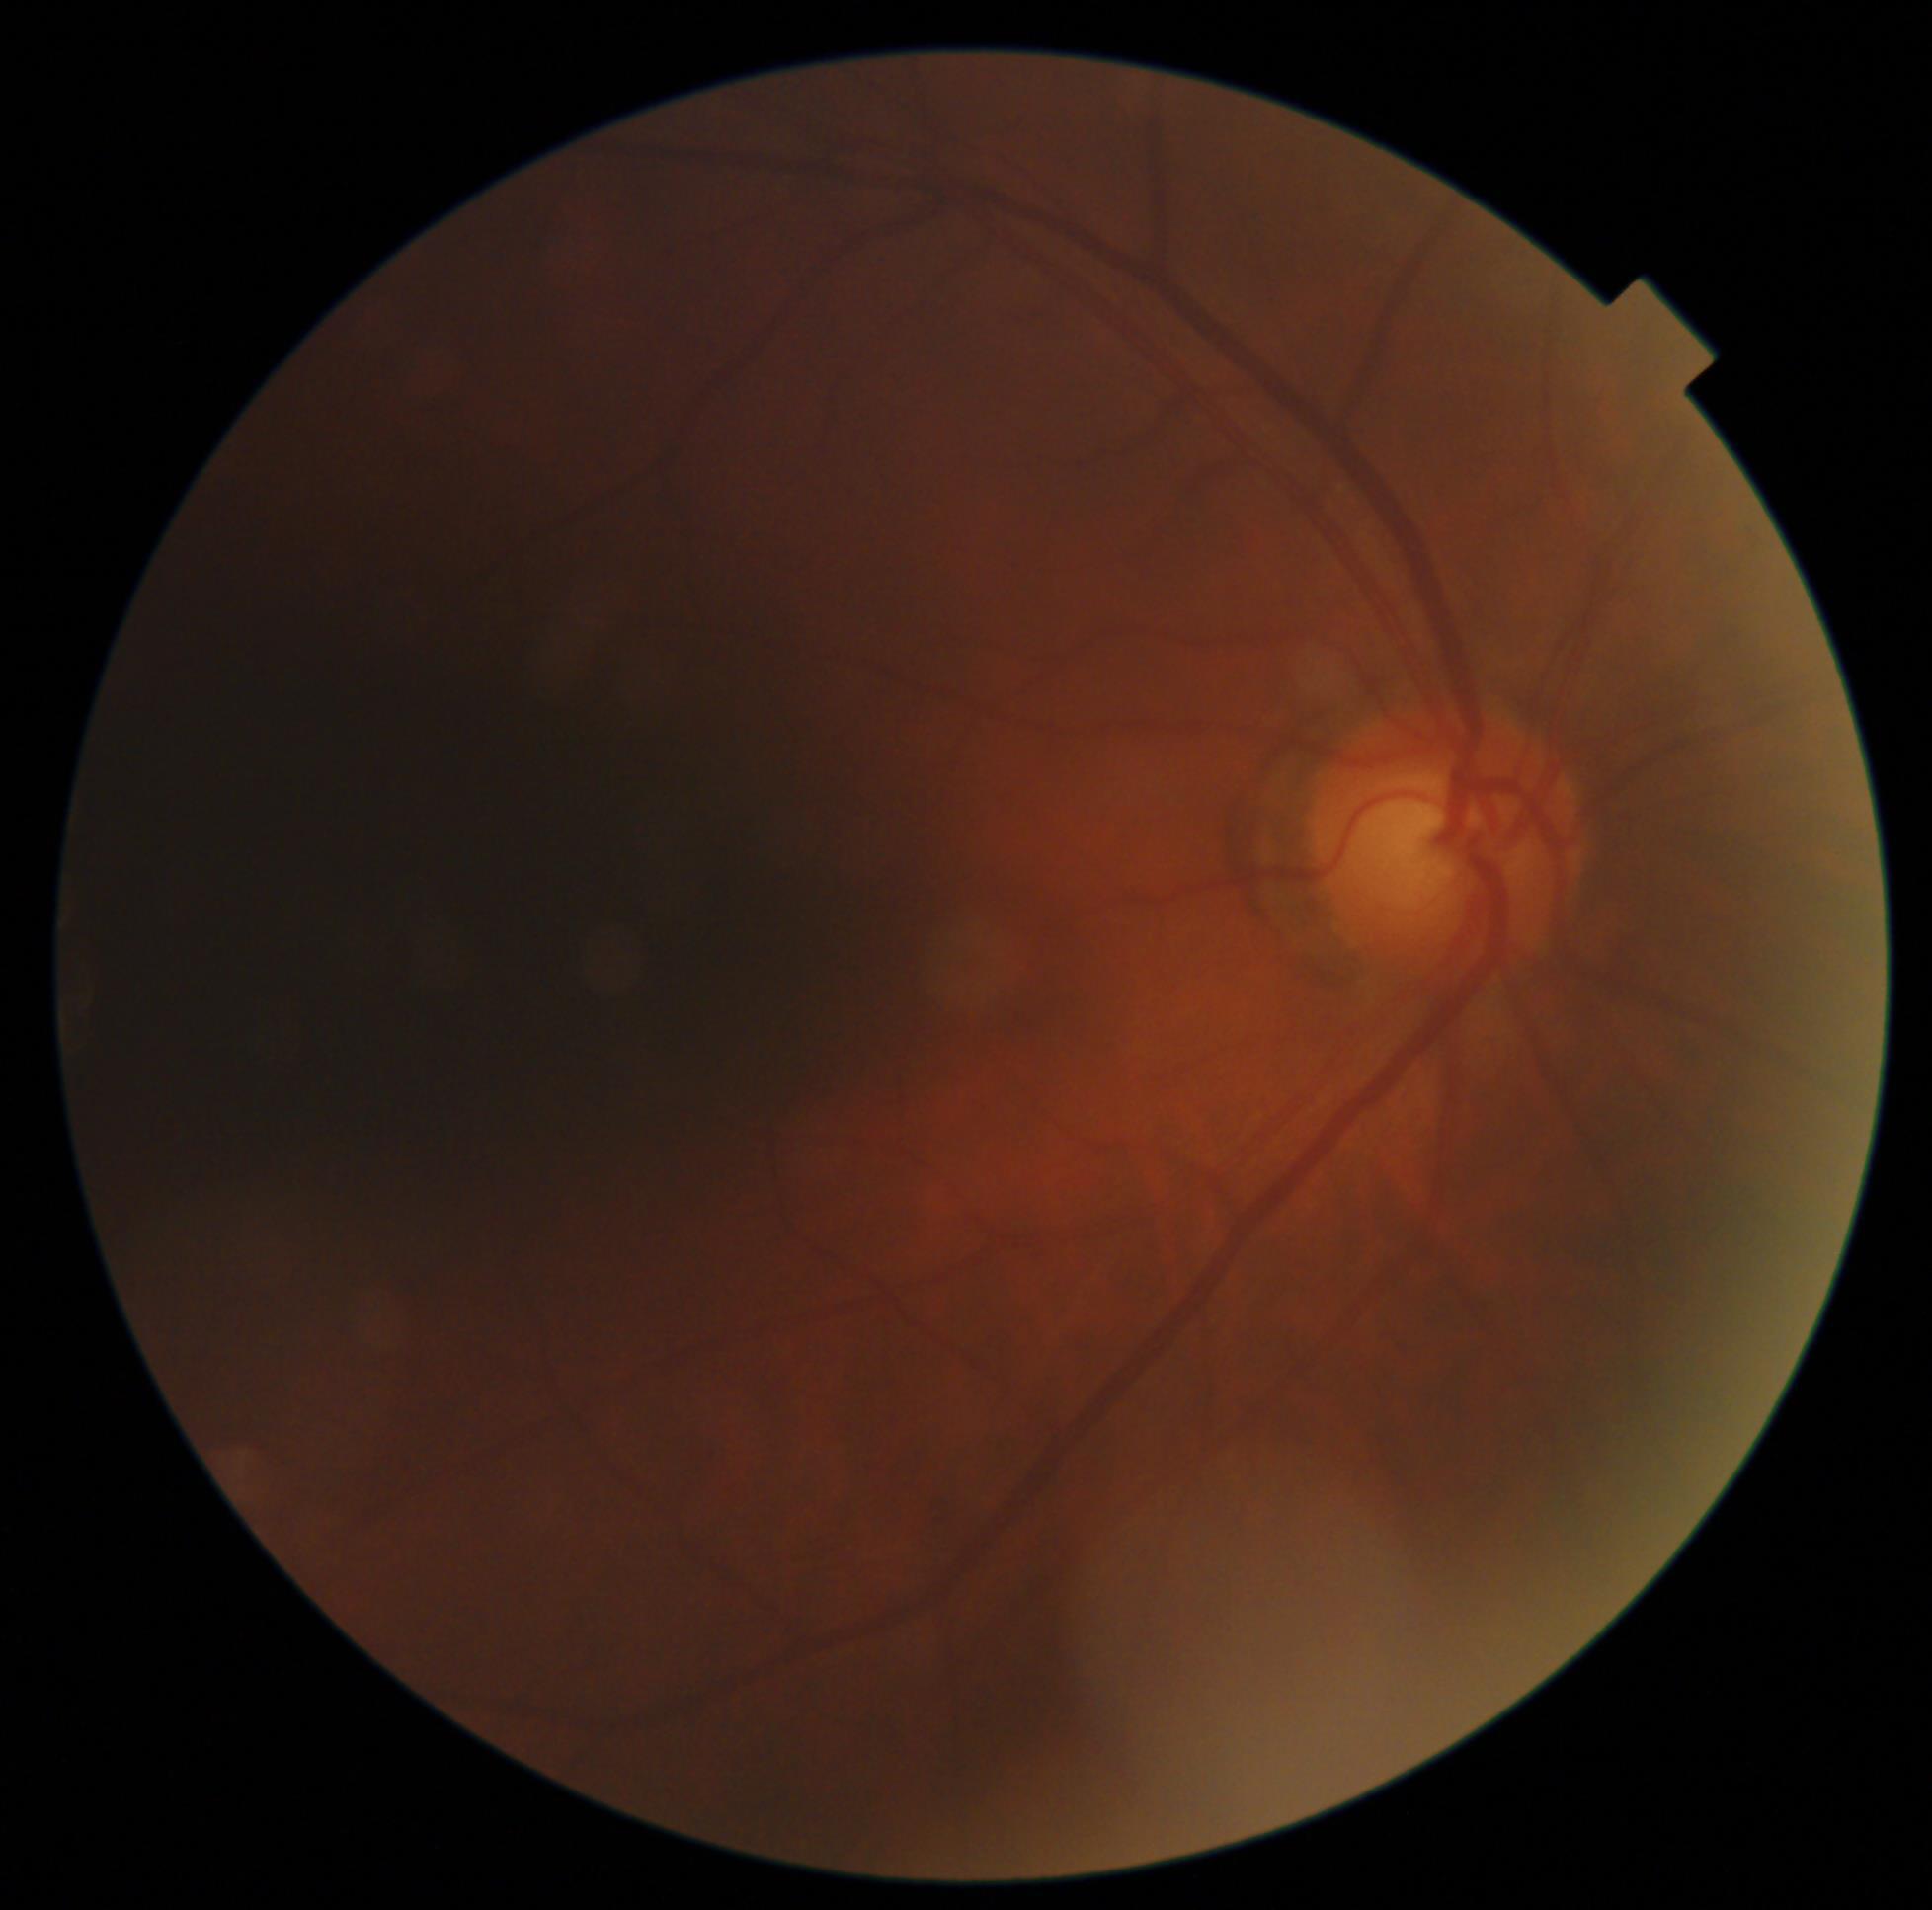 {
  "dr_grade": "grade 0 (no apparent retinopathy) — no visible signs of diabetic retinopathy"
}